1659x2212; Remidio FOP fundus camera: 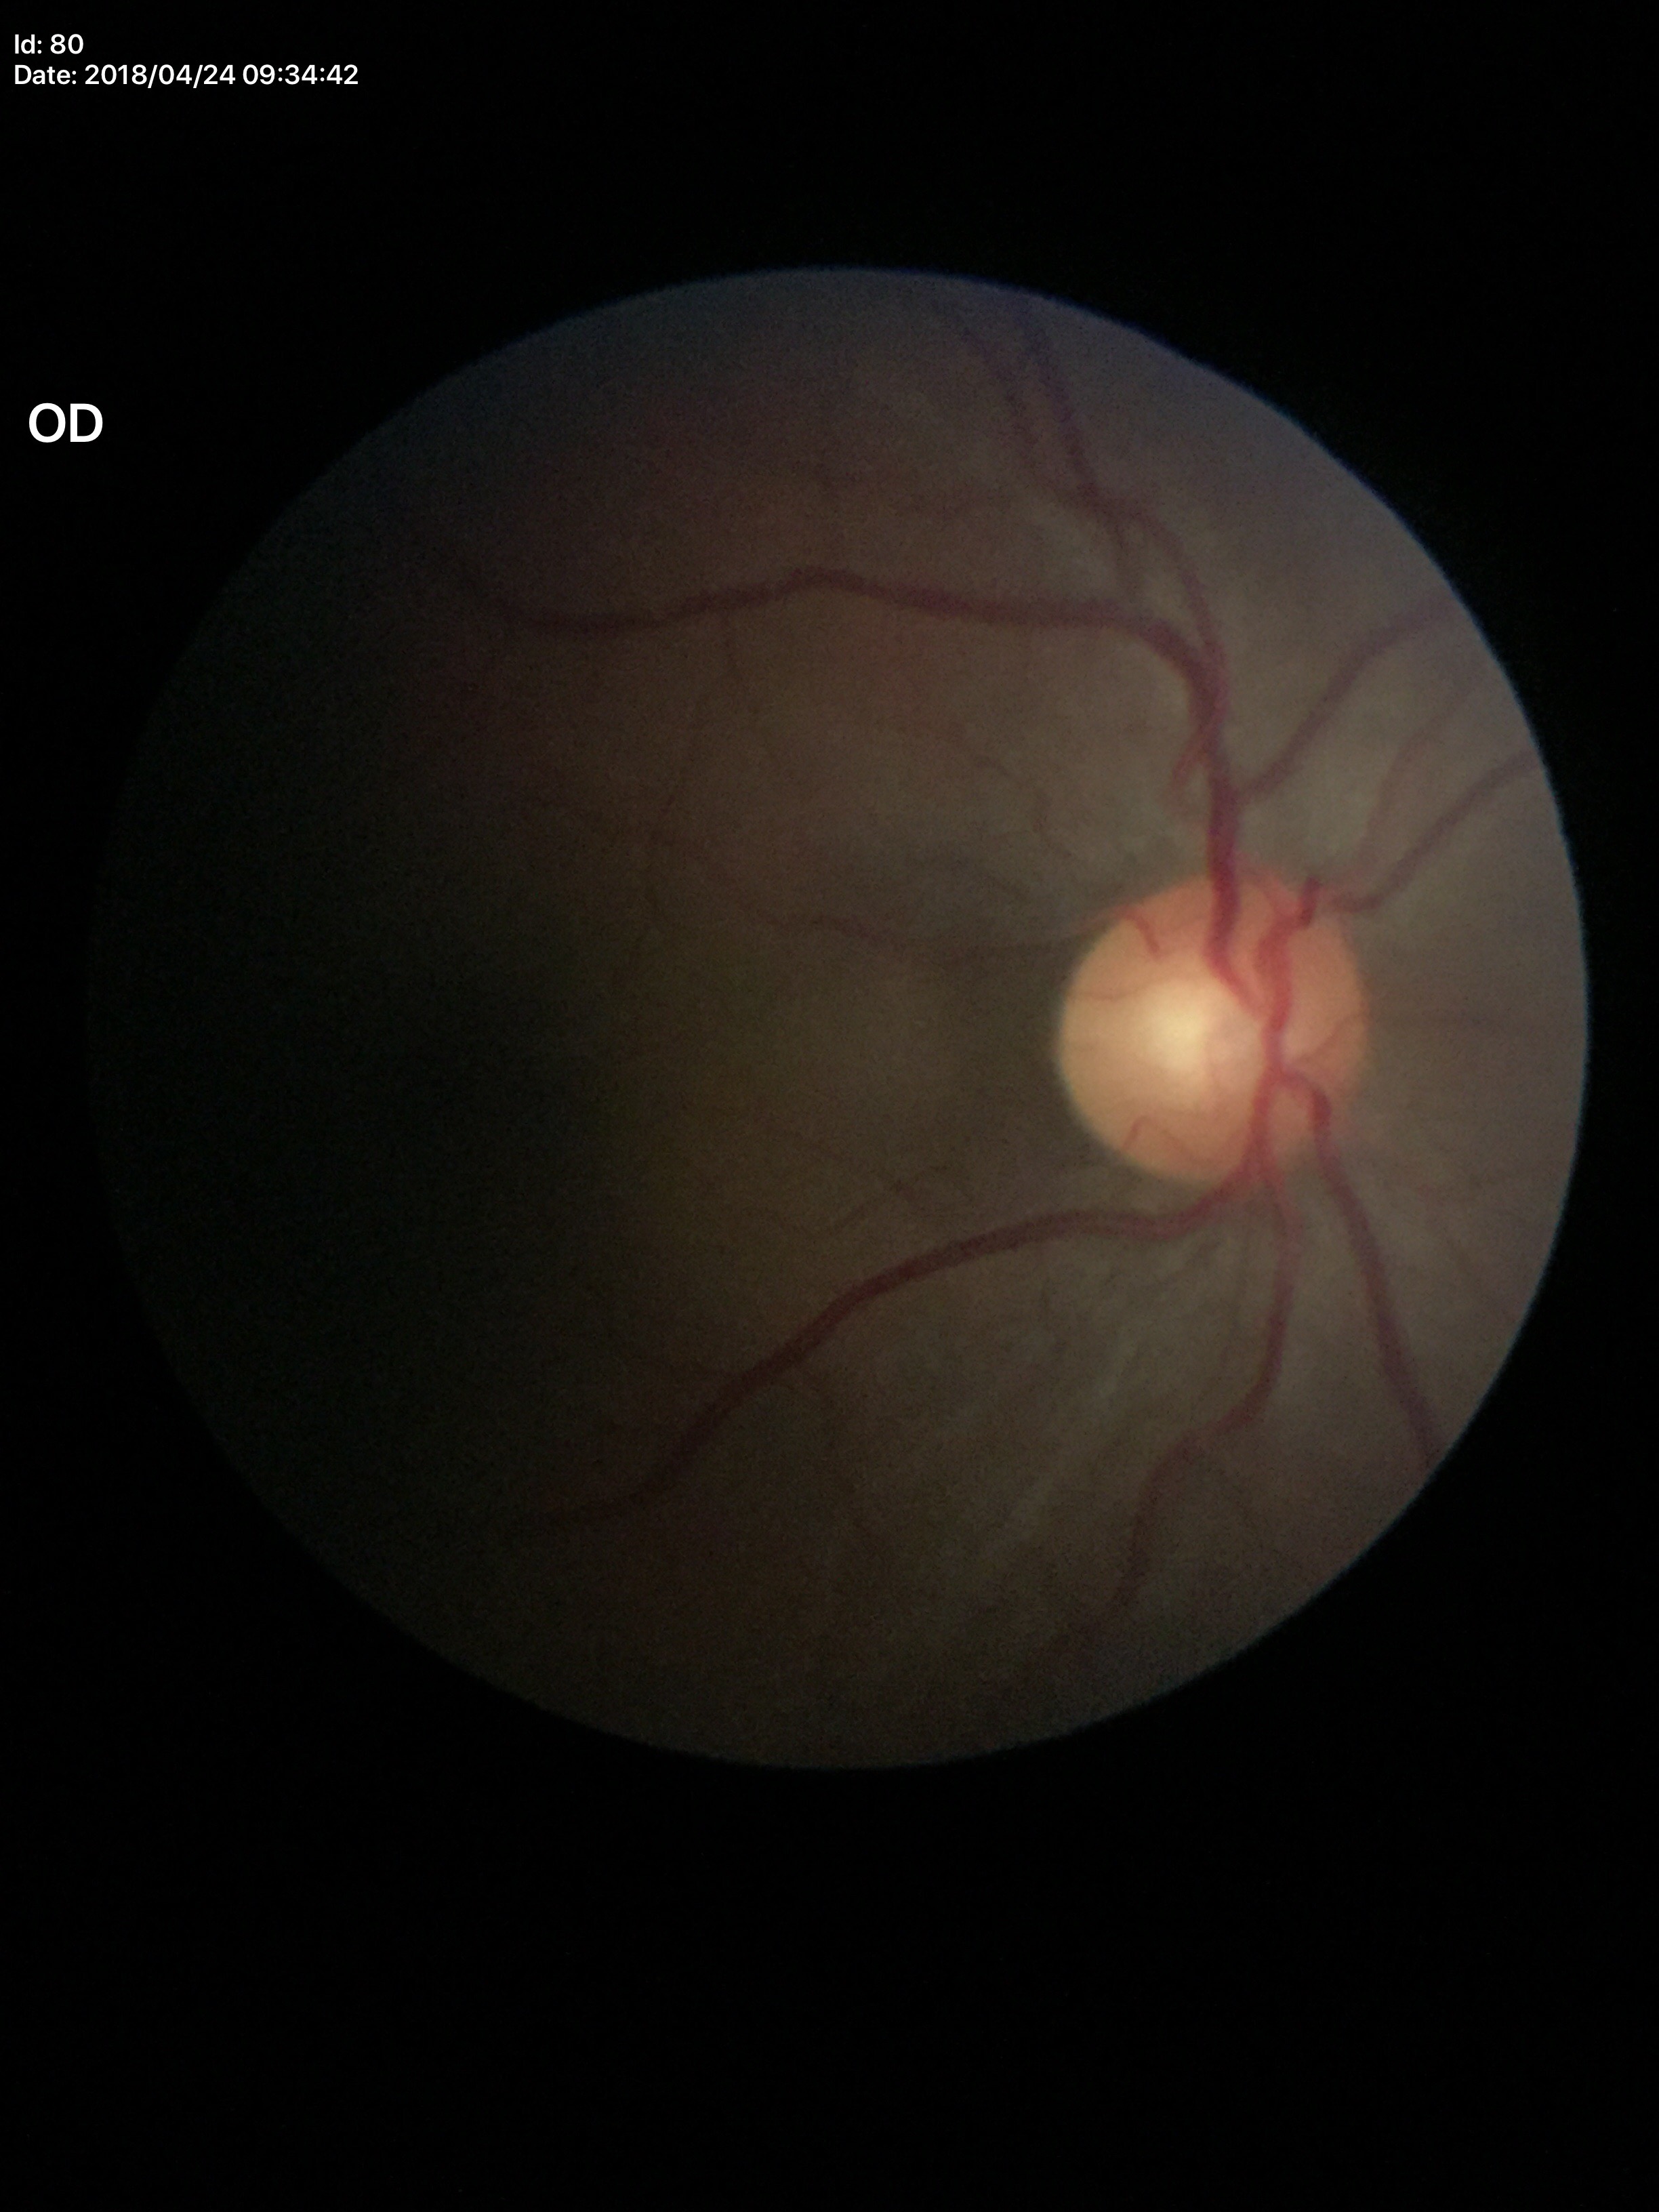

Q: What is the glaucoma assessment?
A: suspicious findings (3/5 graders called glaucoma suspect)
Q: What is the vertical cup-to-disc ratio?
A: 0.58